Acquired with a NIDEK AFC-230:
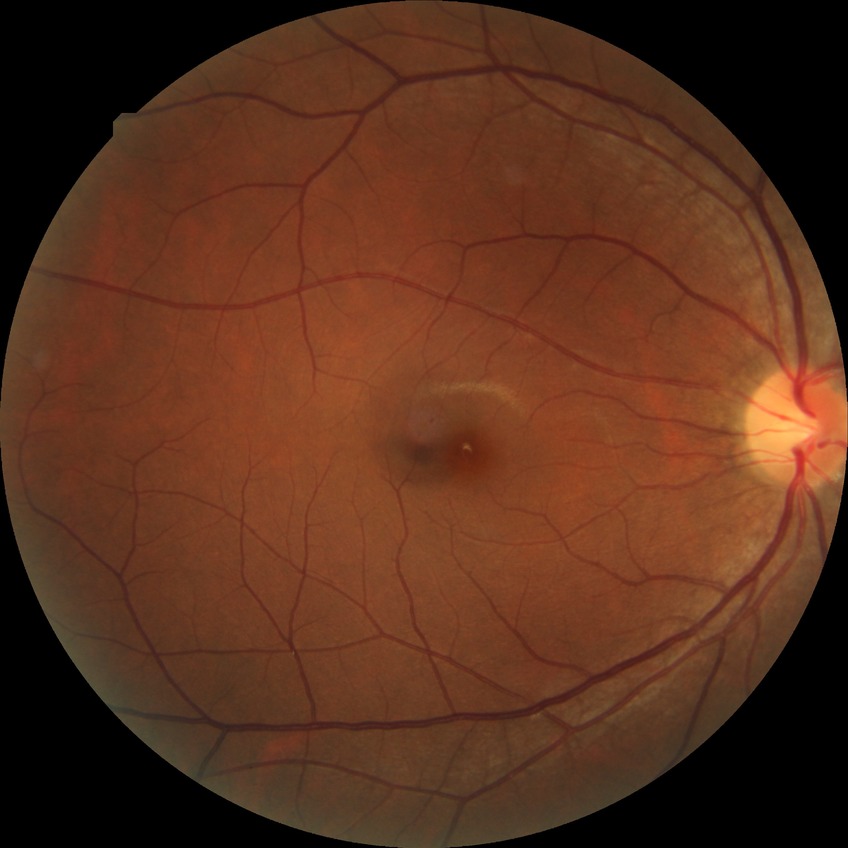
modified Davis grading: simple diabetic retinopathy.